Modified Davis classification:
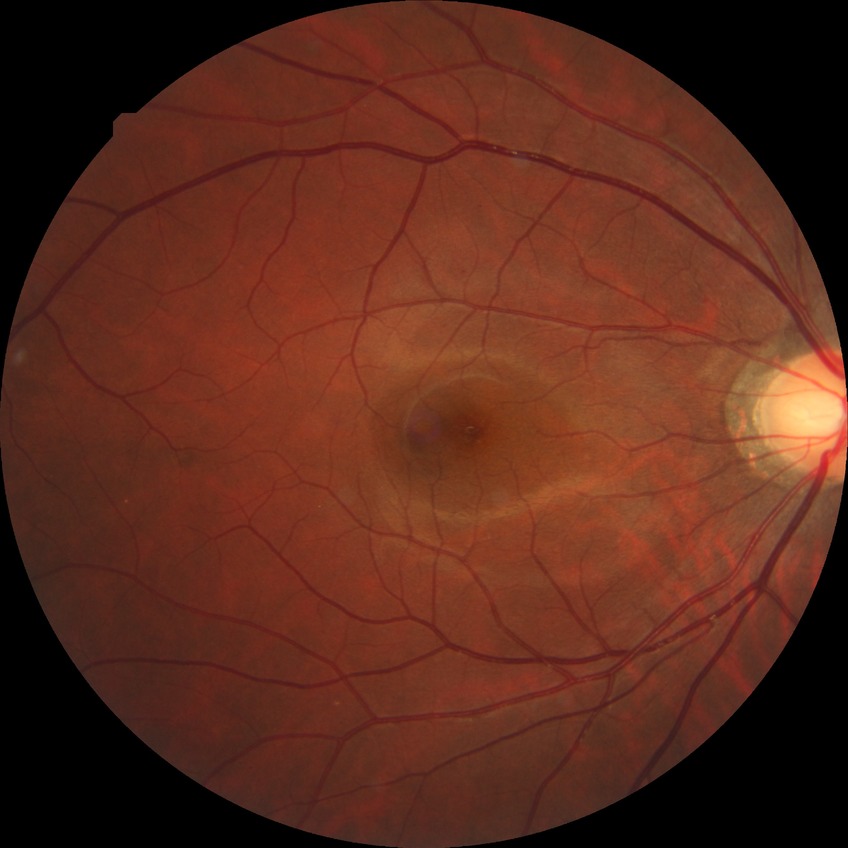
{"davis_grade": "NDR (no diabetic retinopathy)"}